NIDEK AFC-230: 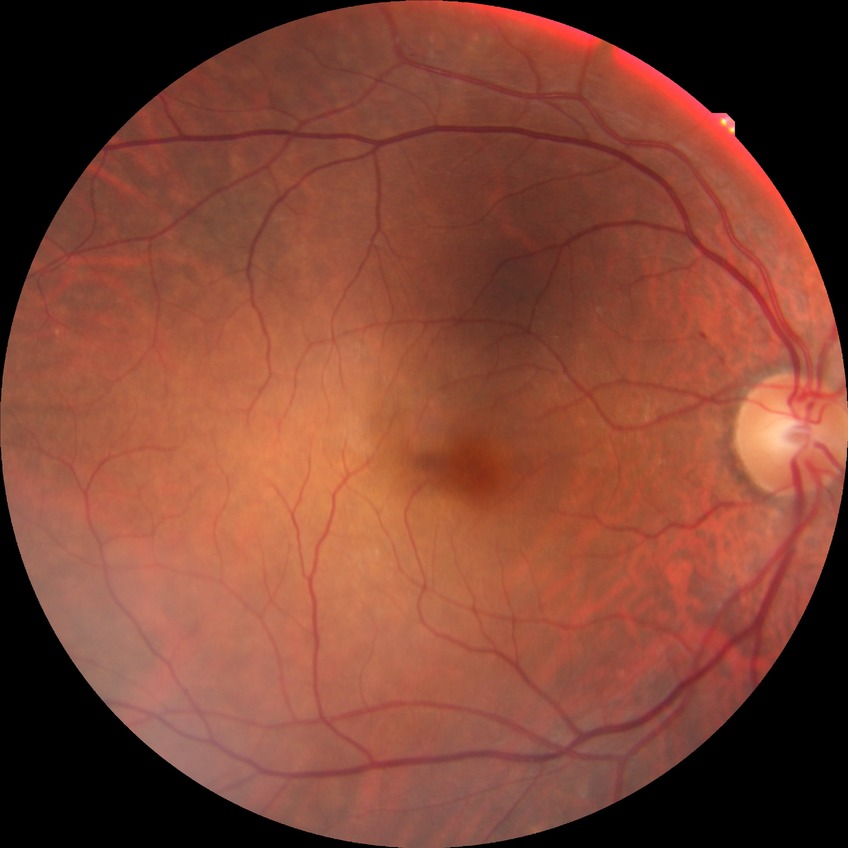
Davis grade is NDR.